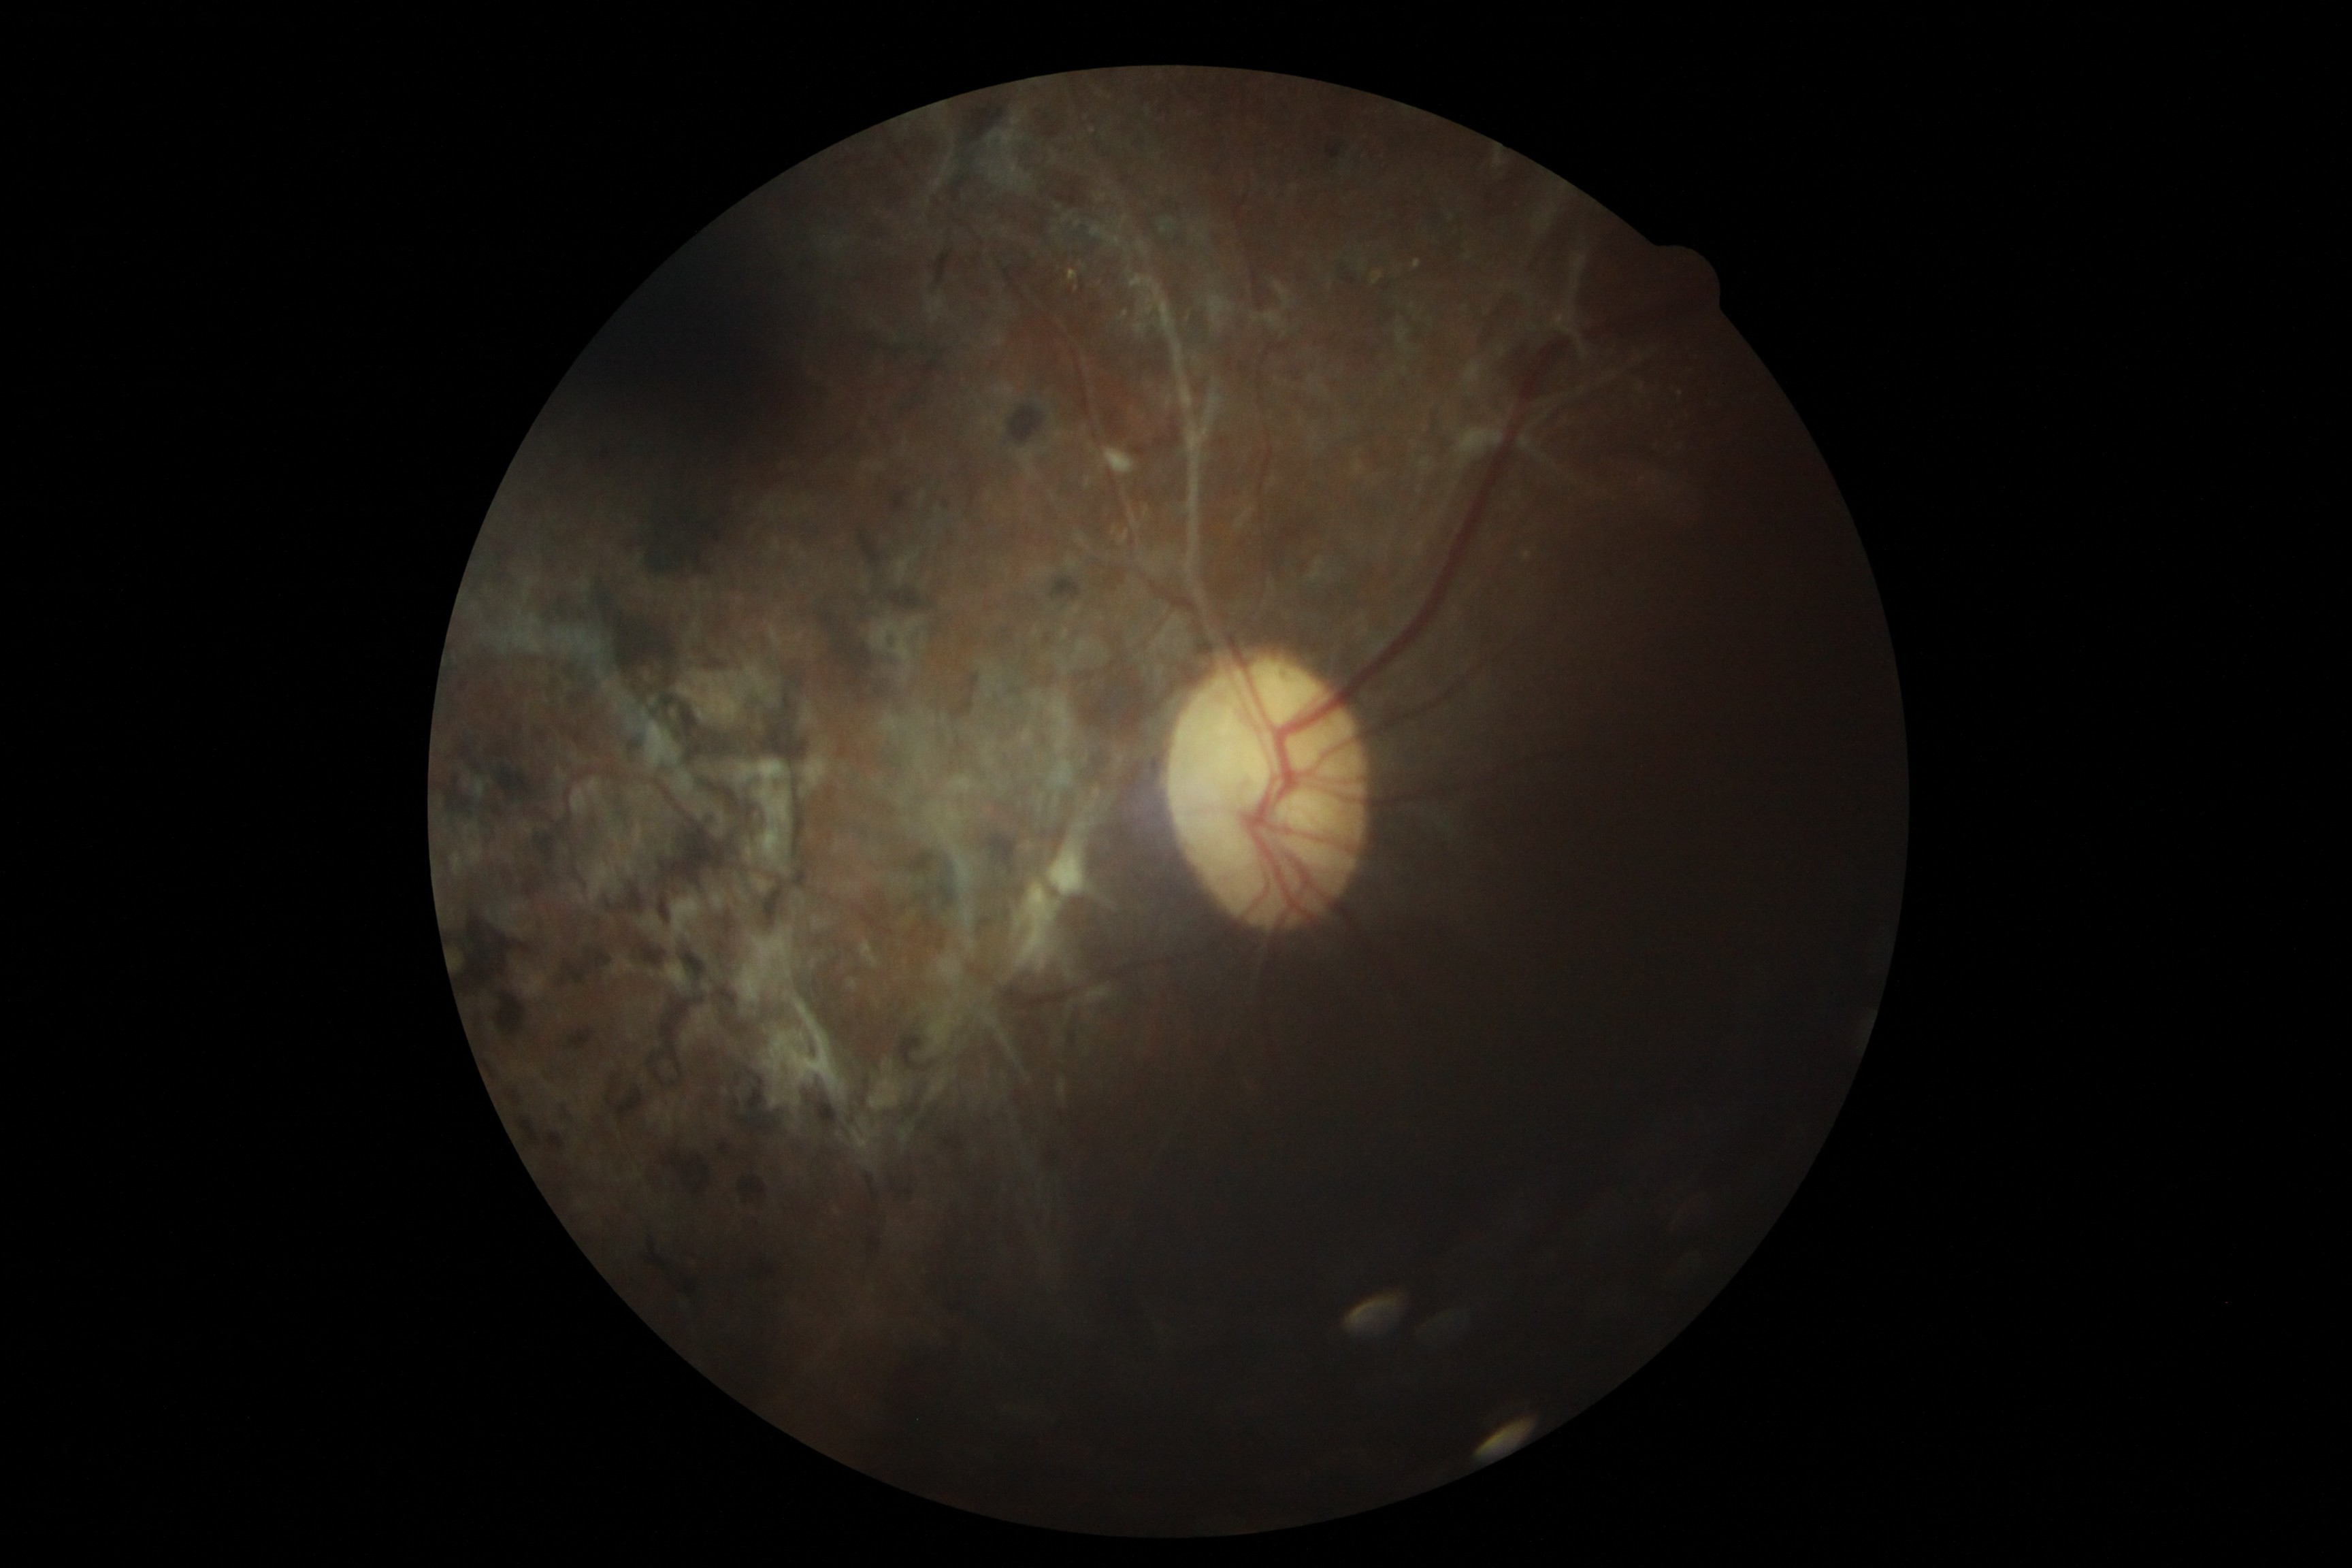 Diabetic retinopathy (DR): grade 4 (PDR).